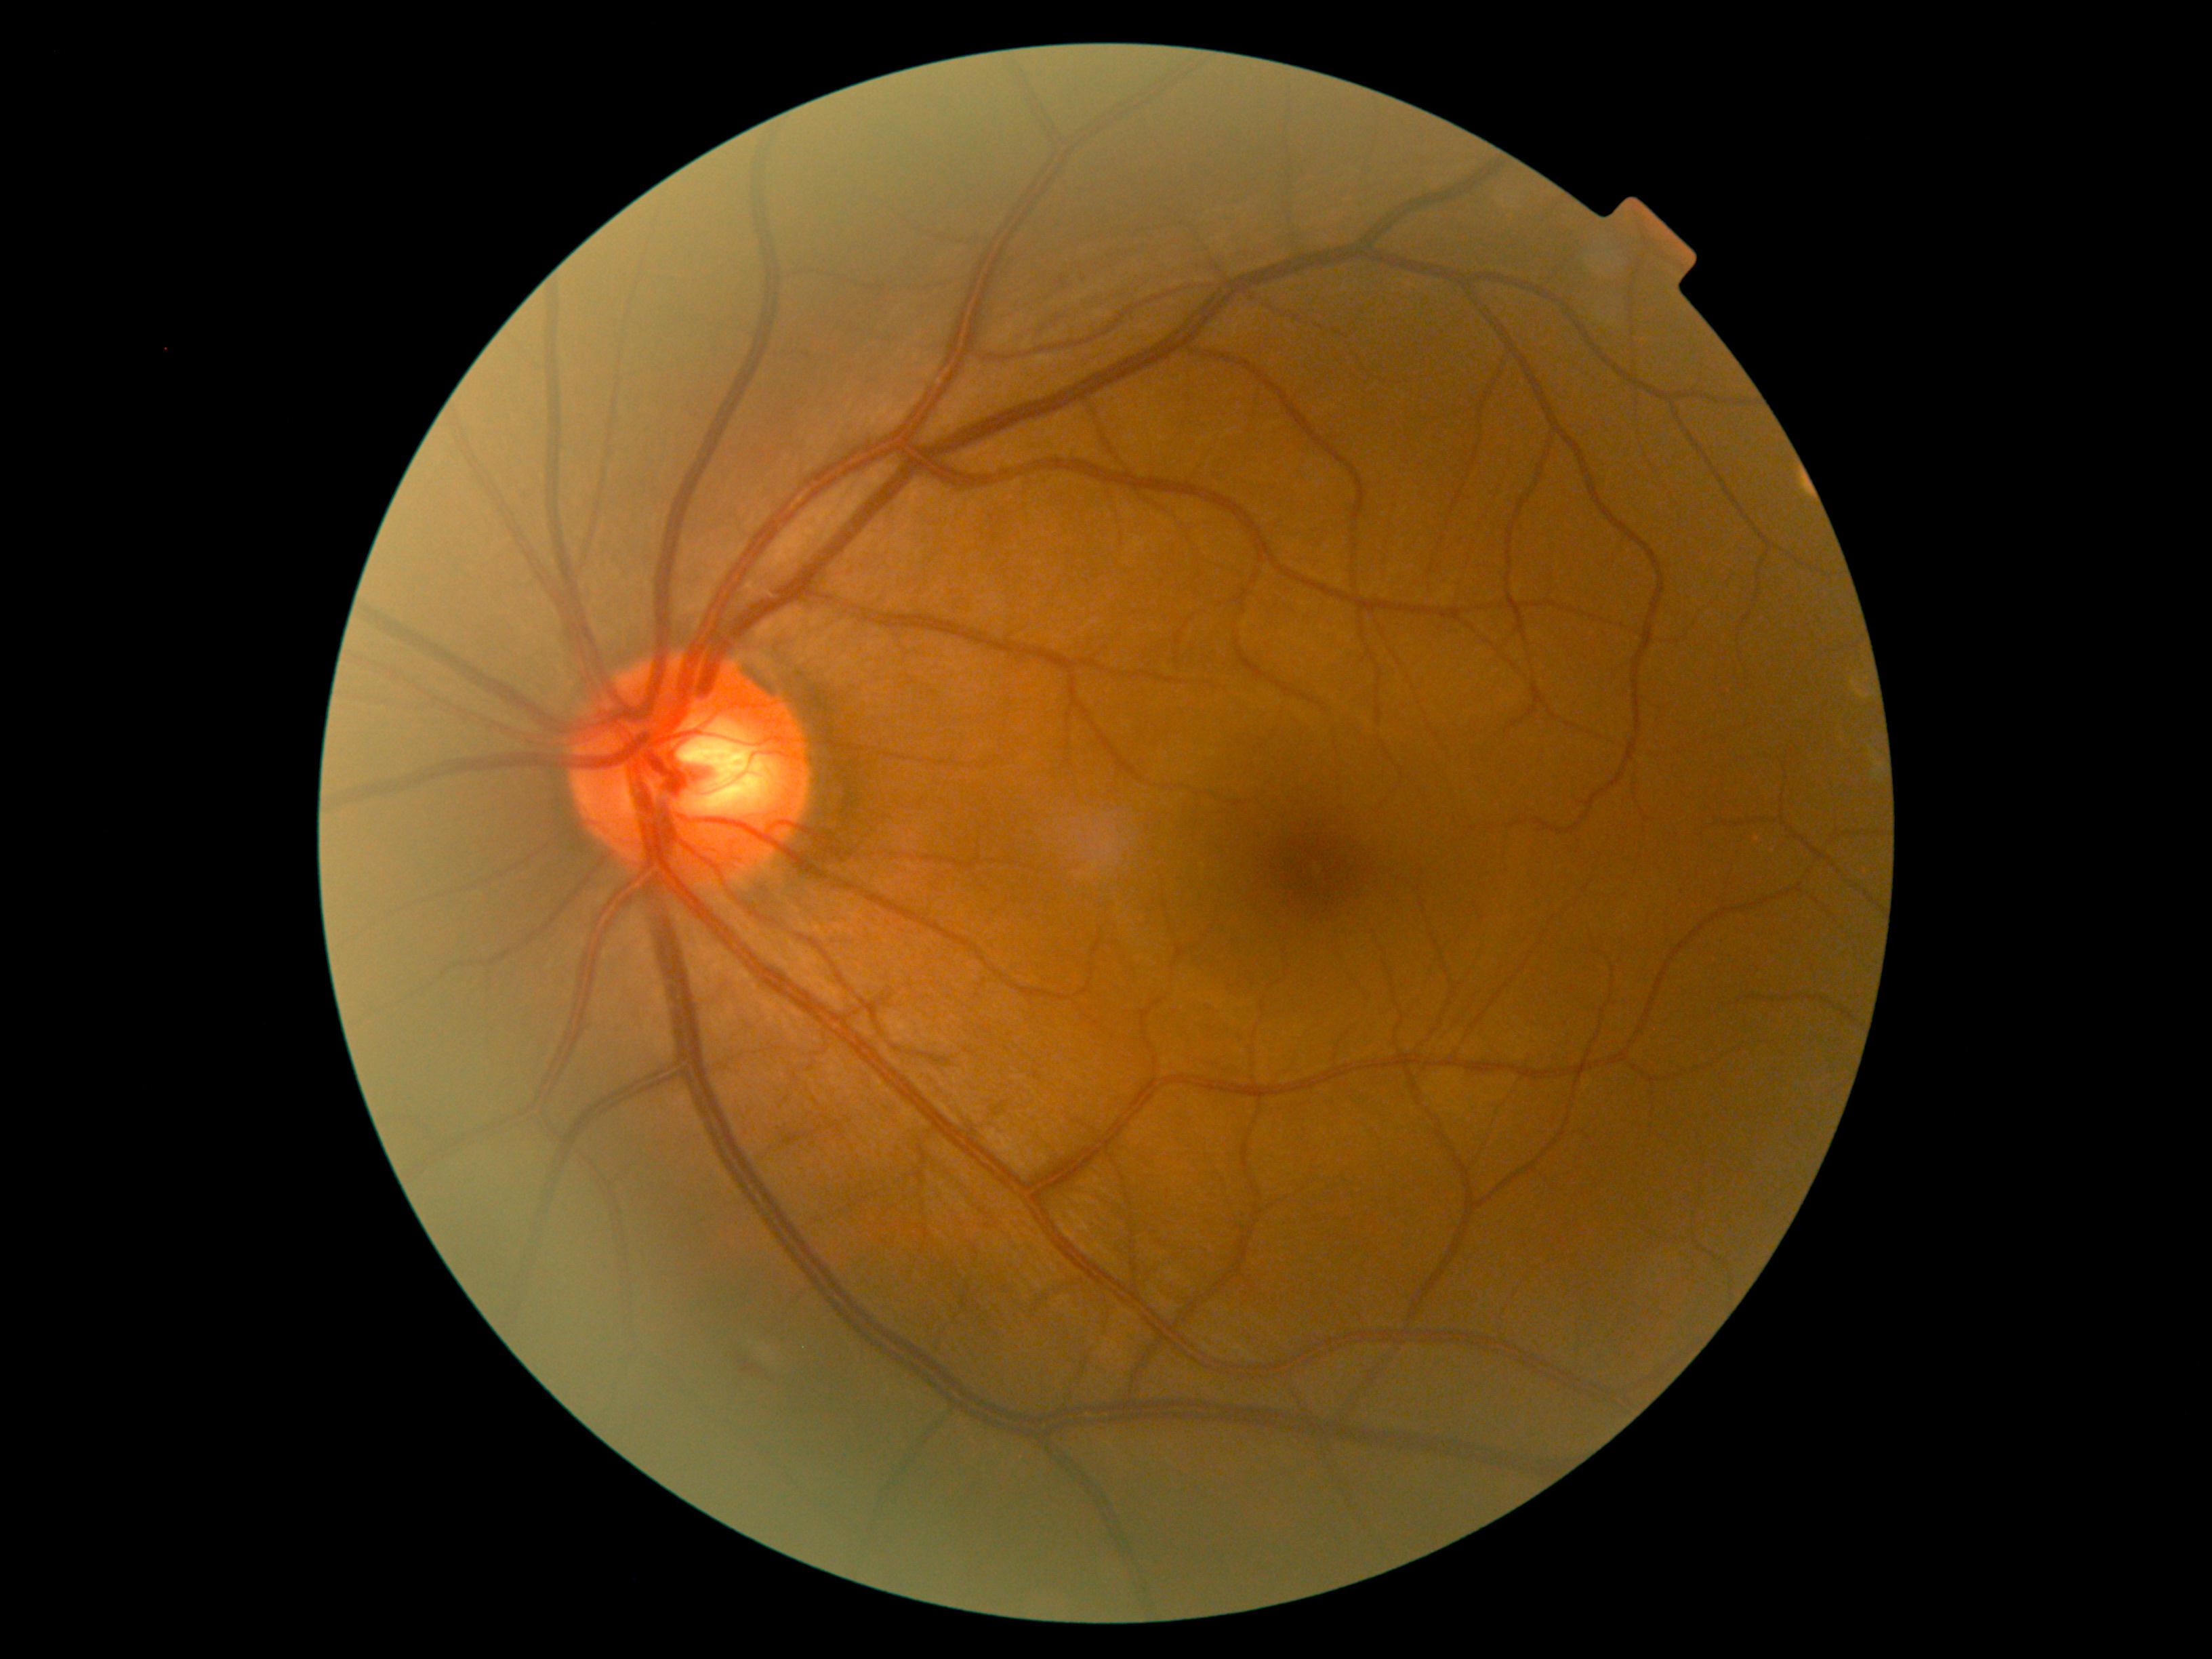
{
  "dr_grade": "2"
}